Central posterior field · FOV: 50 degrees · dilated-pupil acquisition · color fundus photograph · 2228x1652.
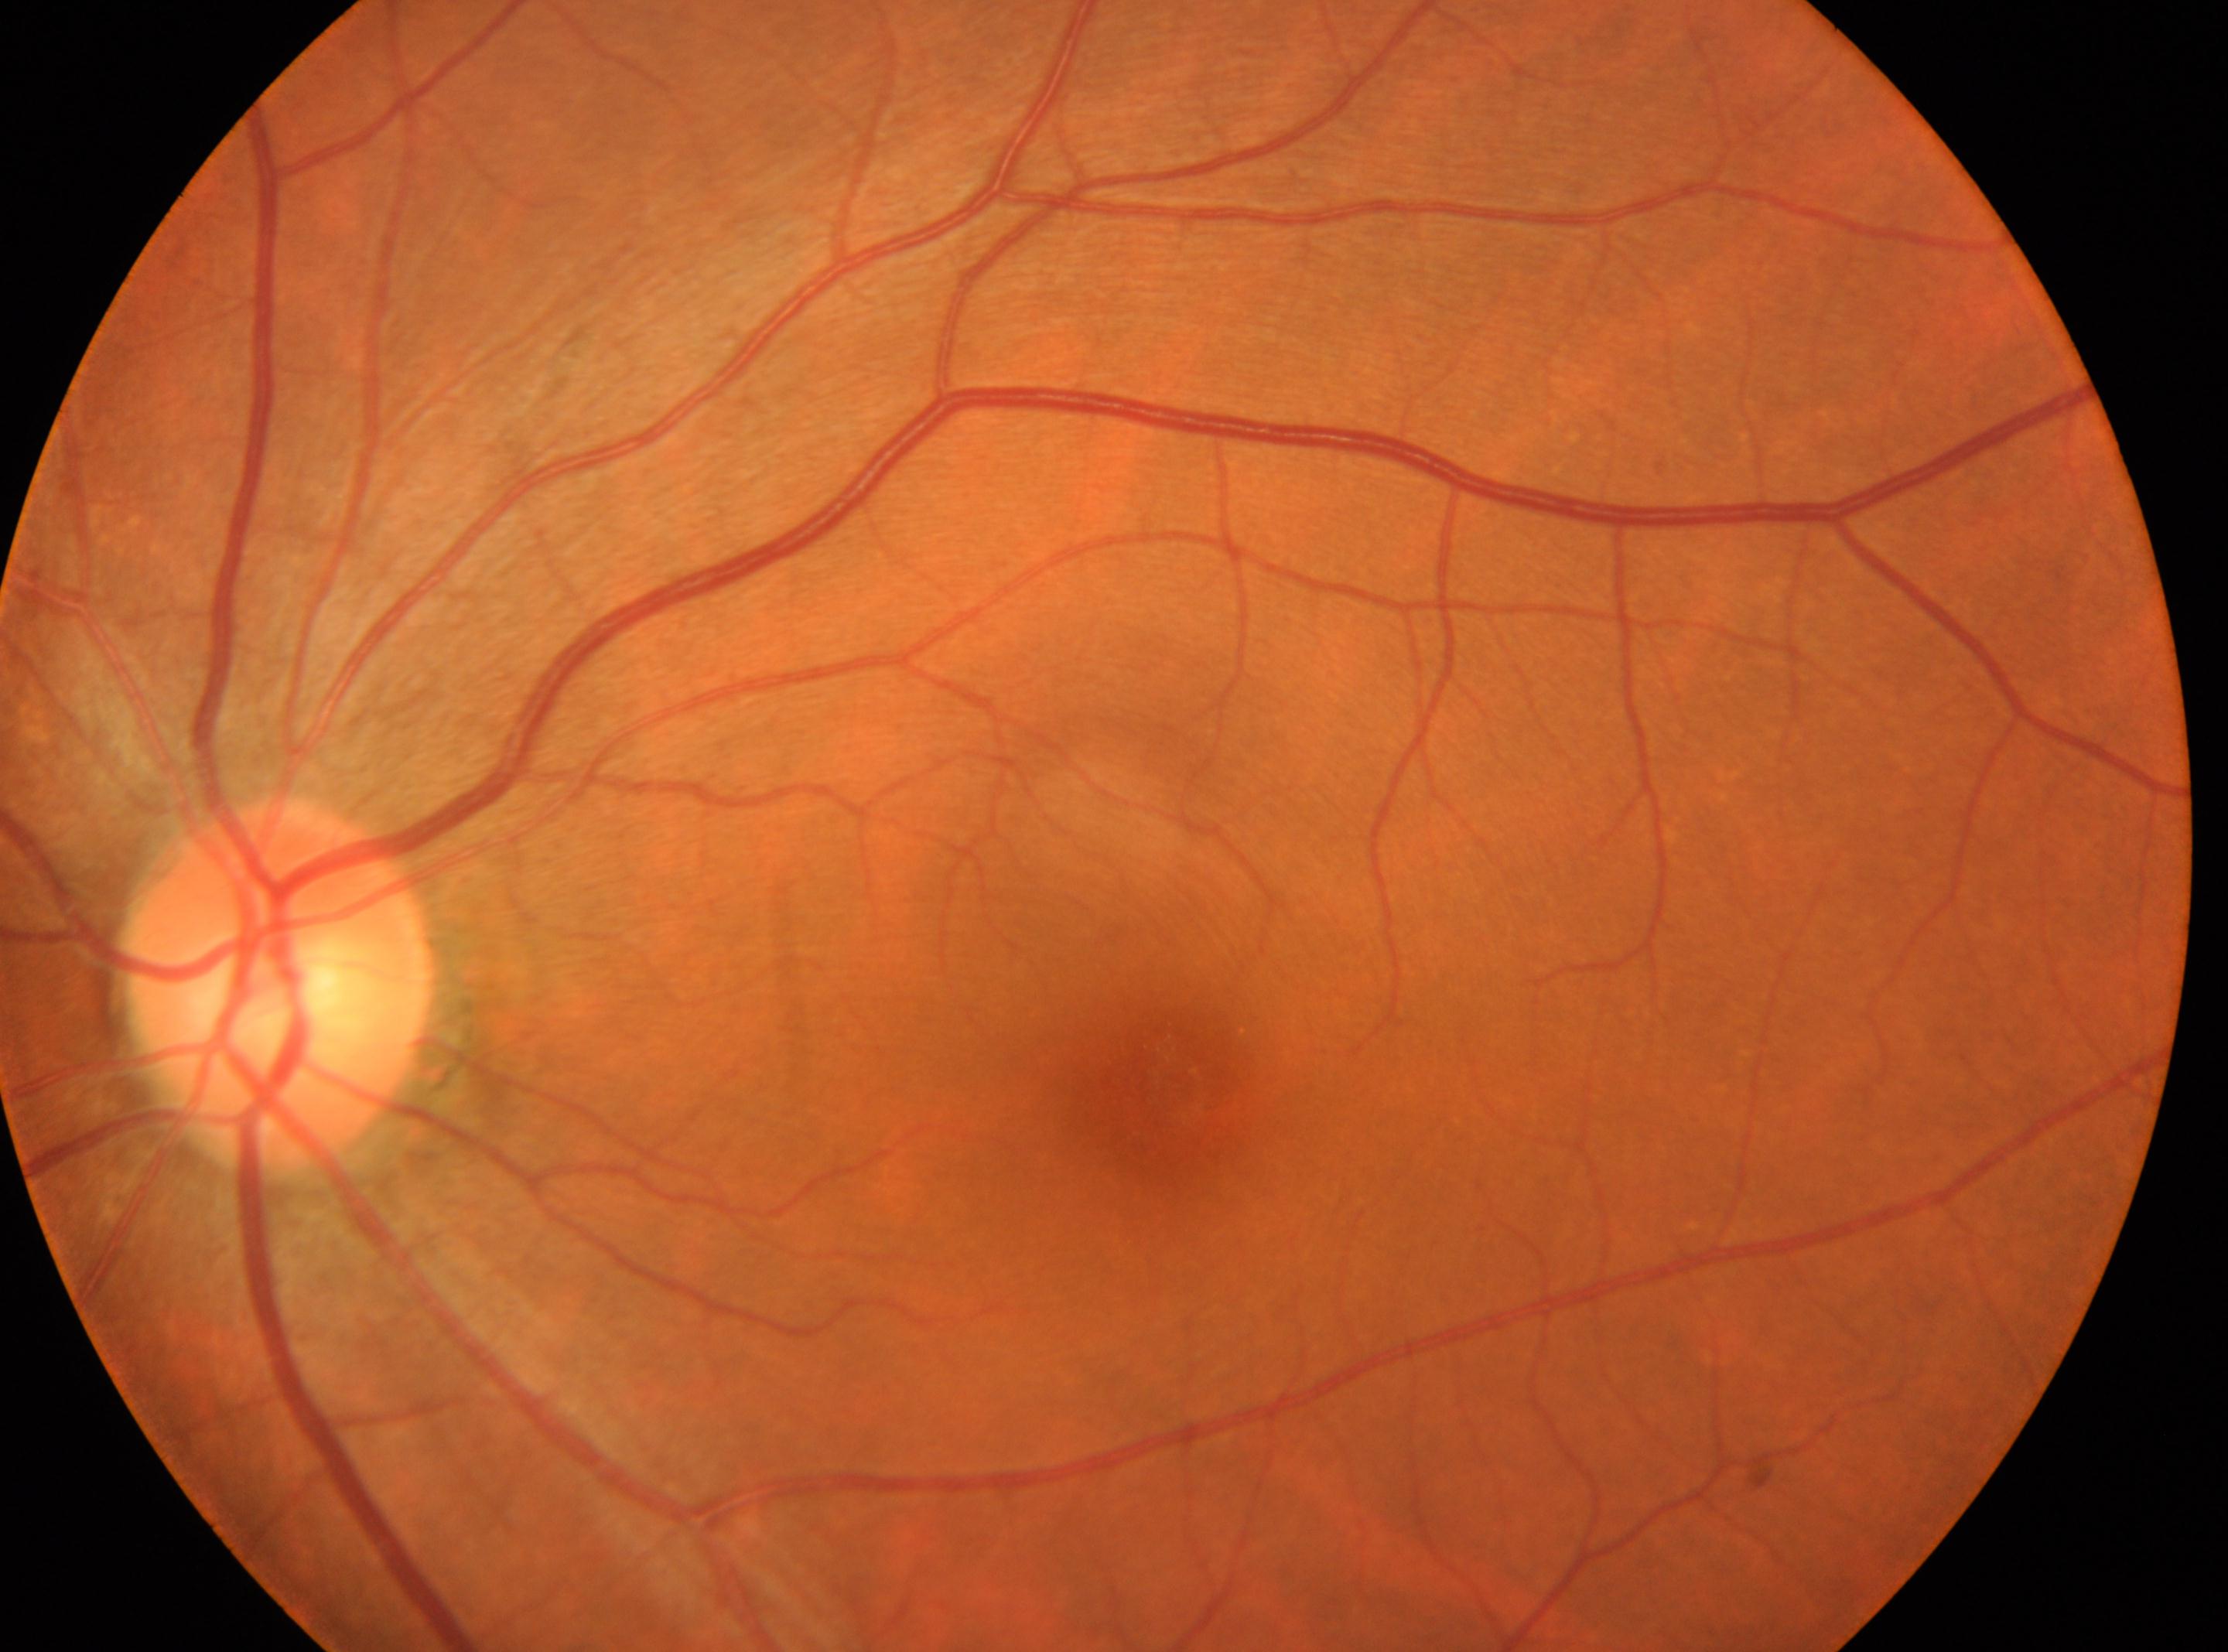

laterality = left eye; DR impression = No signs of diabetic retinopathy; retinopathy = grade 0 (no apparent retinopathy); the fovea = 1167px, 1077px; optic disc center = 277px, 988px.